Nonmydriatic, color fundus image, 45° field of view, acquired with a NIDEK AFC-230:
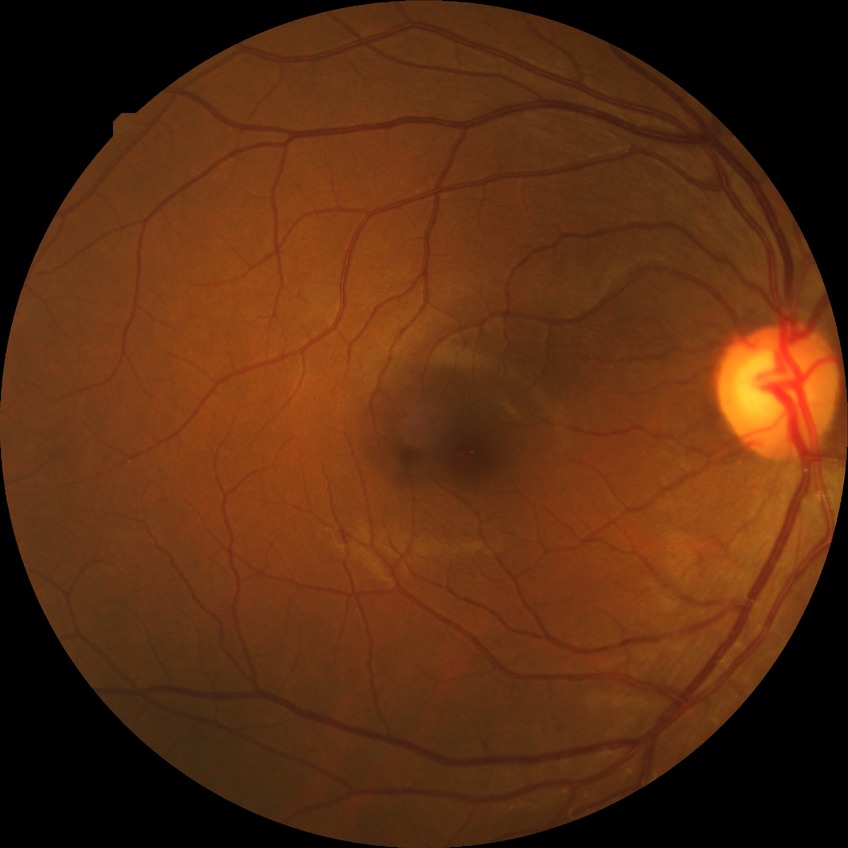

Annotations:
* diabetic retinopathy grade — no diabetic retinopathy